FOV: 45 degrees: 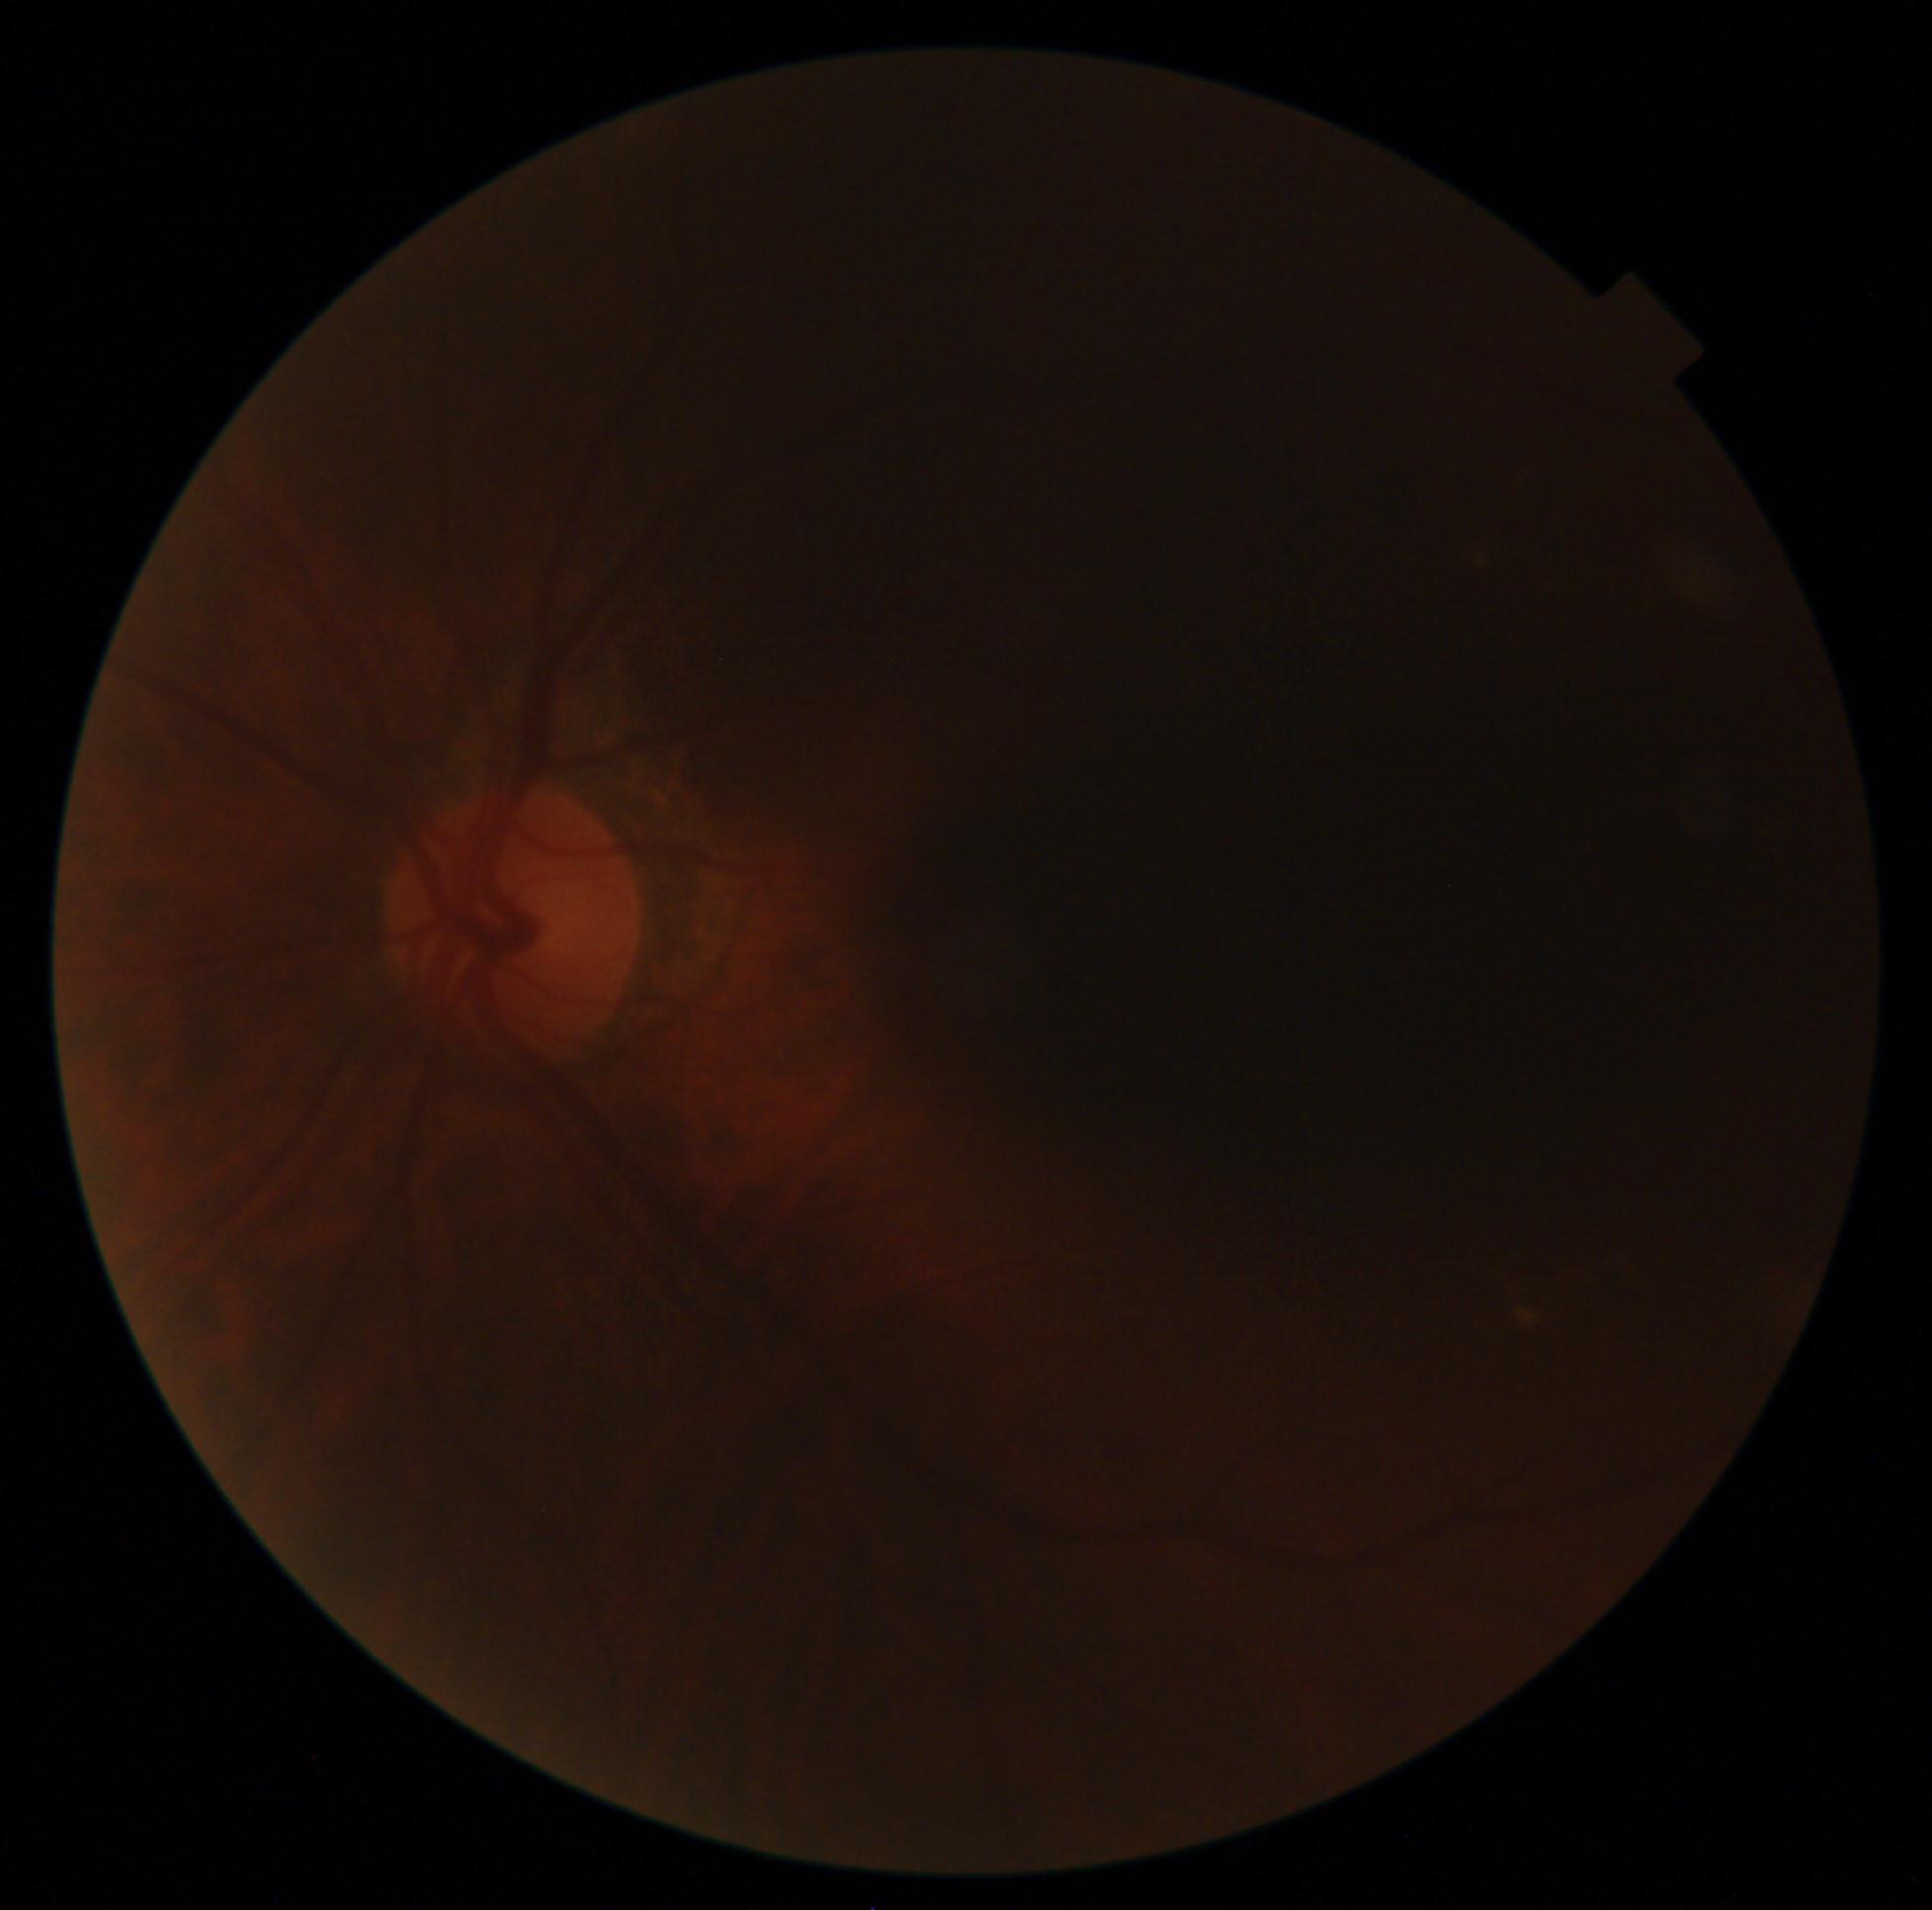
Diabetic retinopathy grade is ungradable due to poor image quality.